DR severity per modified Davis staging: 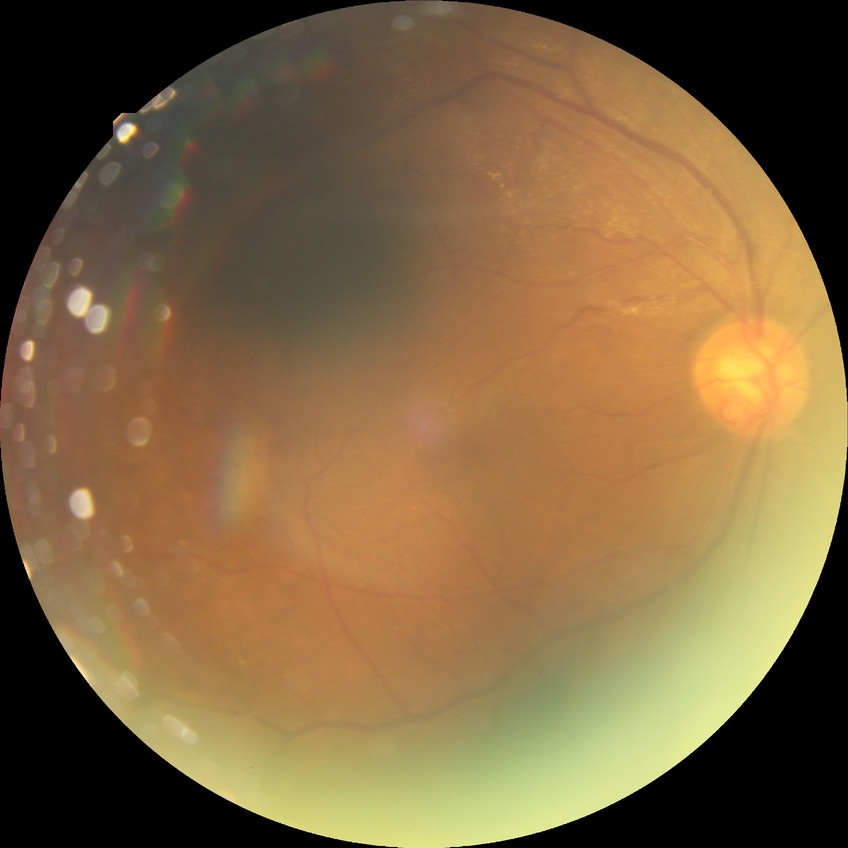

Diabetic retinopathy (DR): PDR (proliferative diabetic retinopathy).